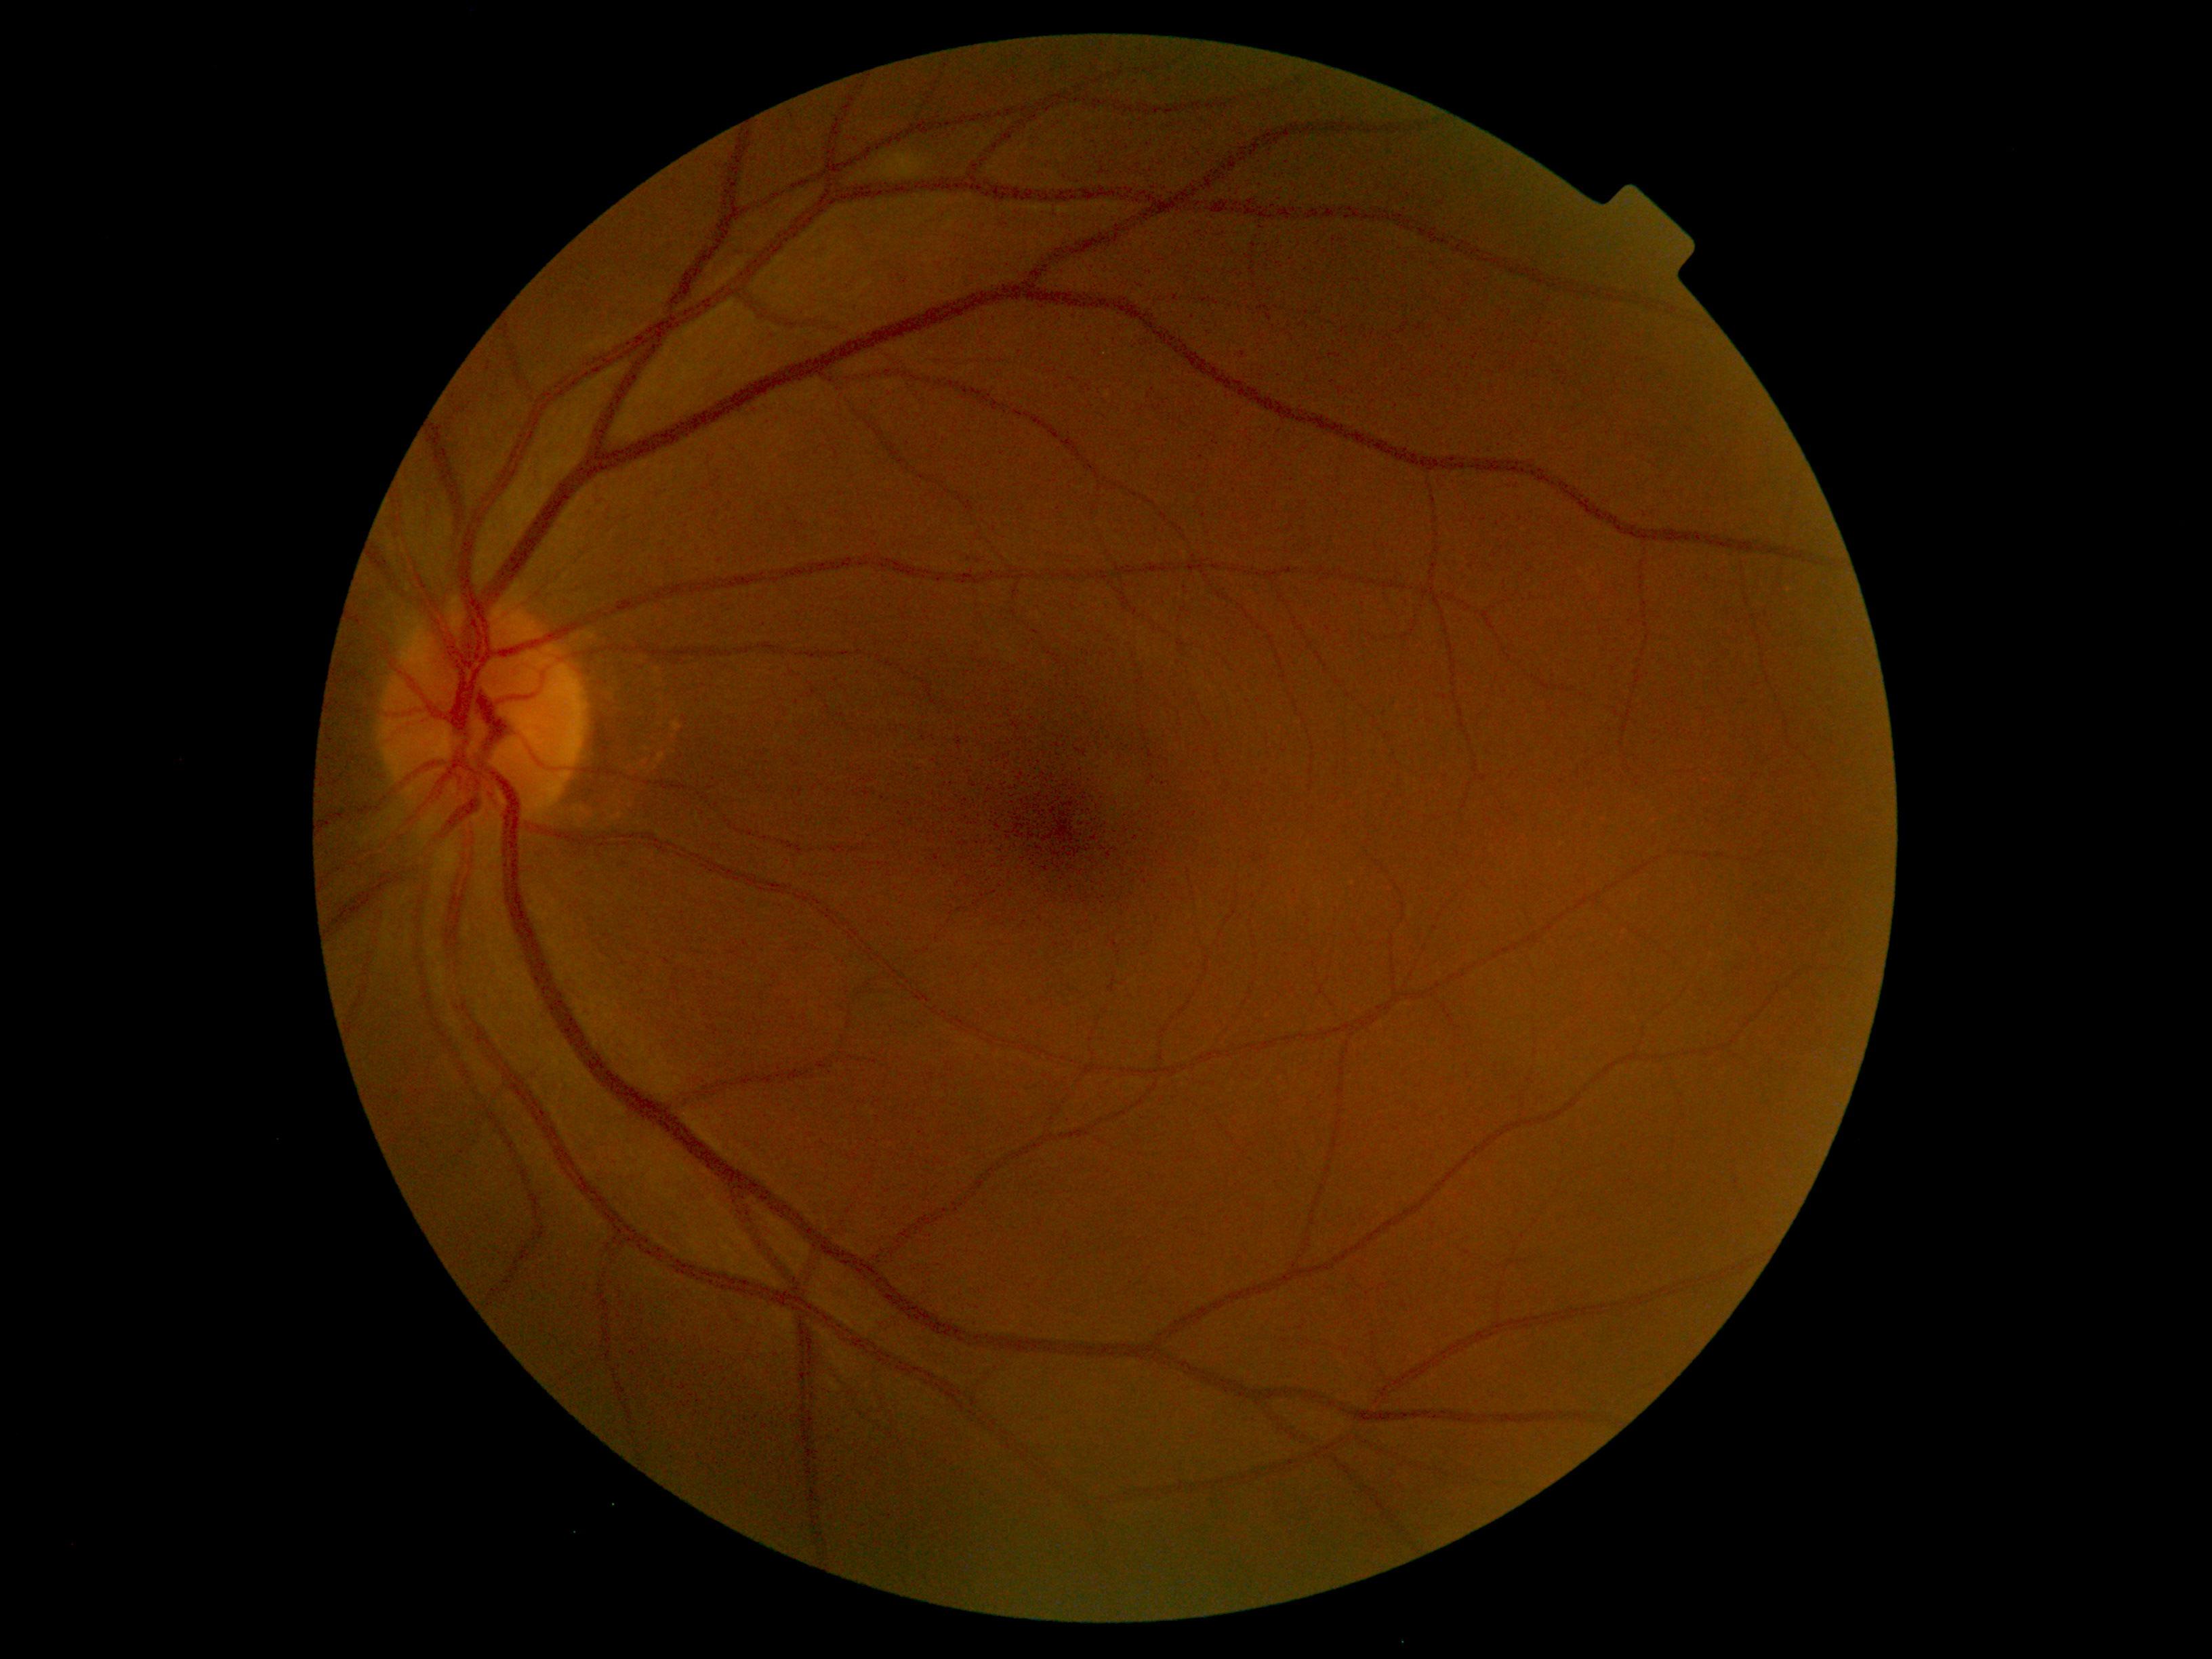
Diabetic retinopathy severity is 2.